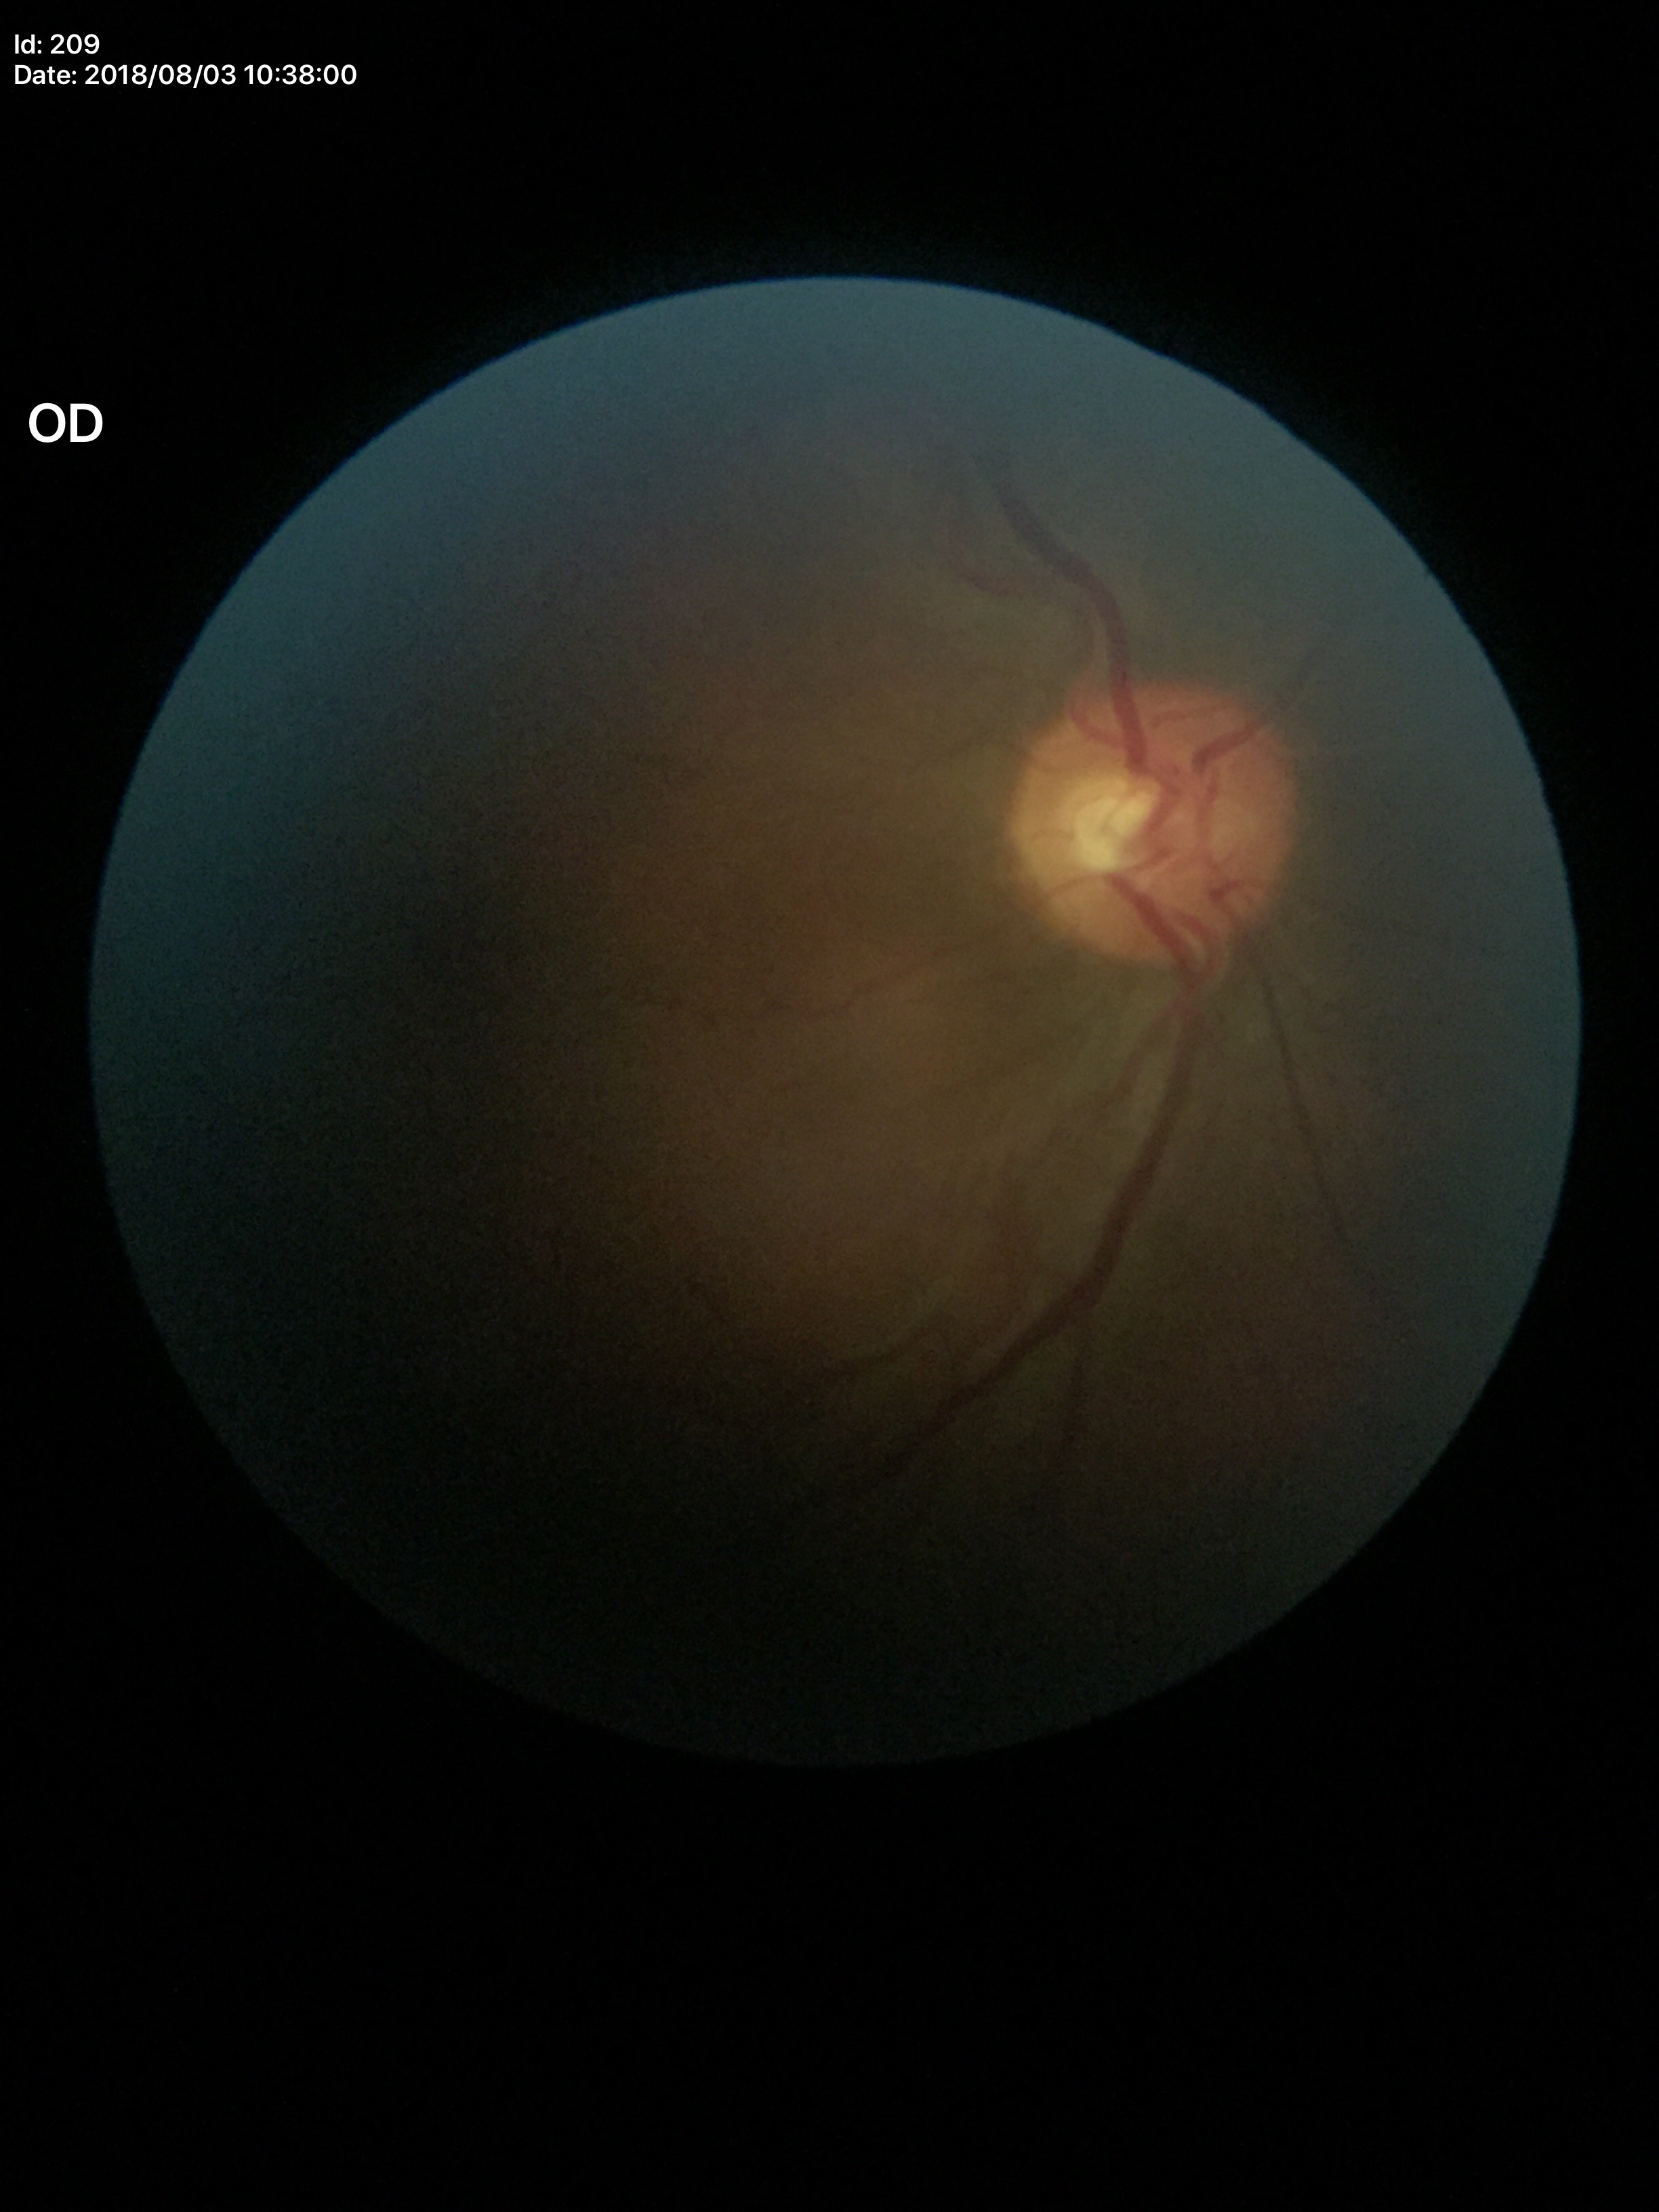

No signs of glaucoma. Vertical cup-to-disc ratio (VCDR) of 0.41. Horizontal cup-to-disc ratio (HCDR) is 0.48.